Graded on the modified Davis scale · nonmydriatic fundus photograph — 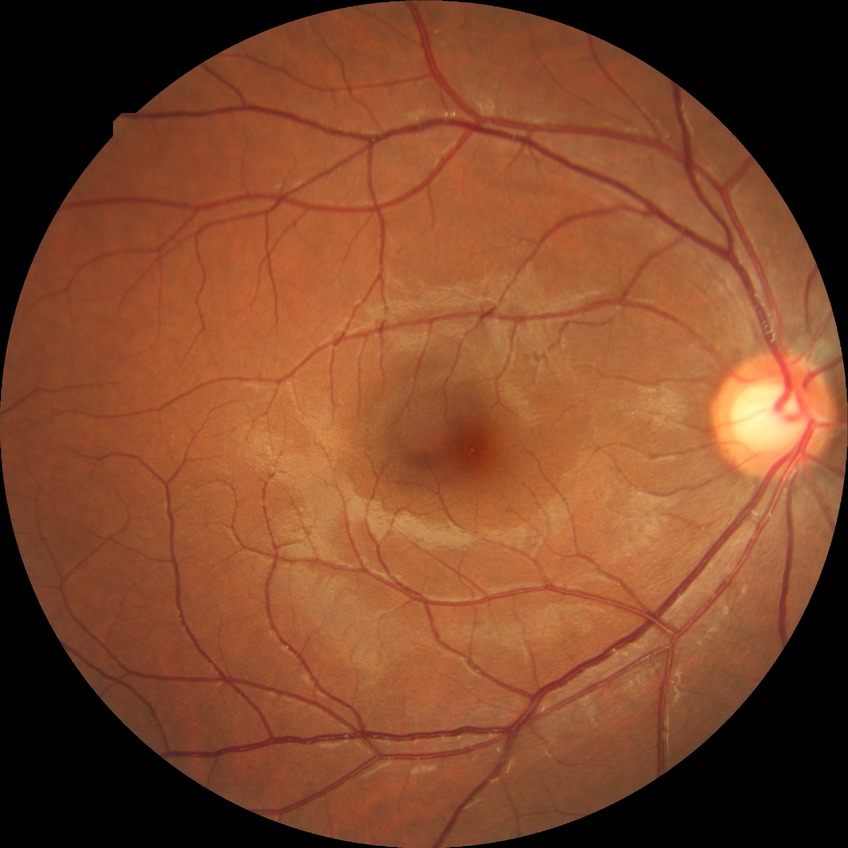

Diabetic retinopathy grade: no diabetic retinopathy.